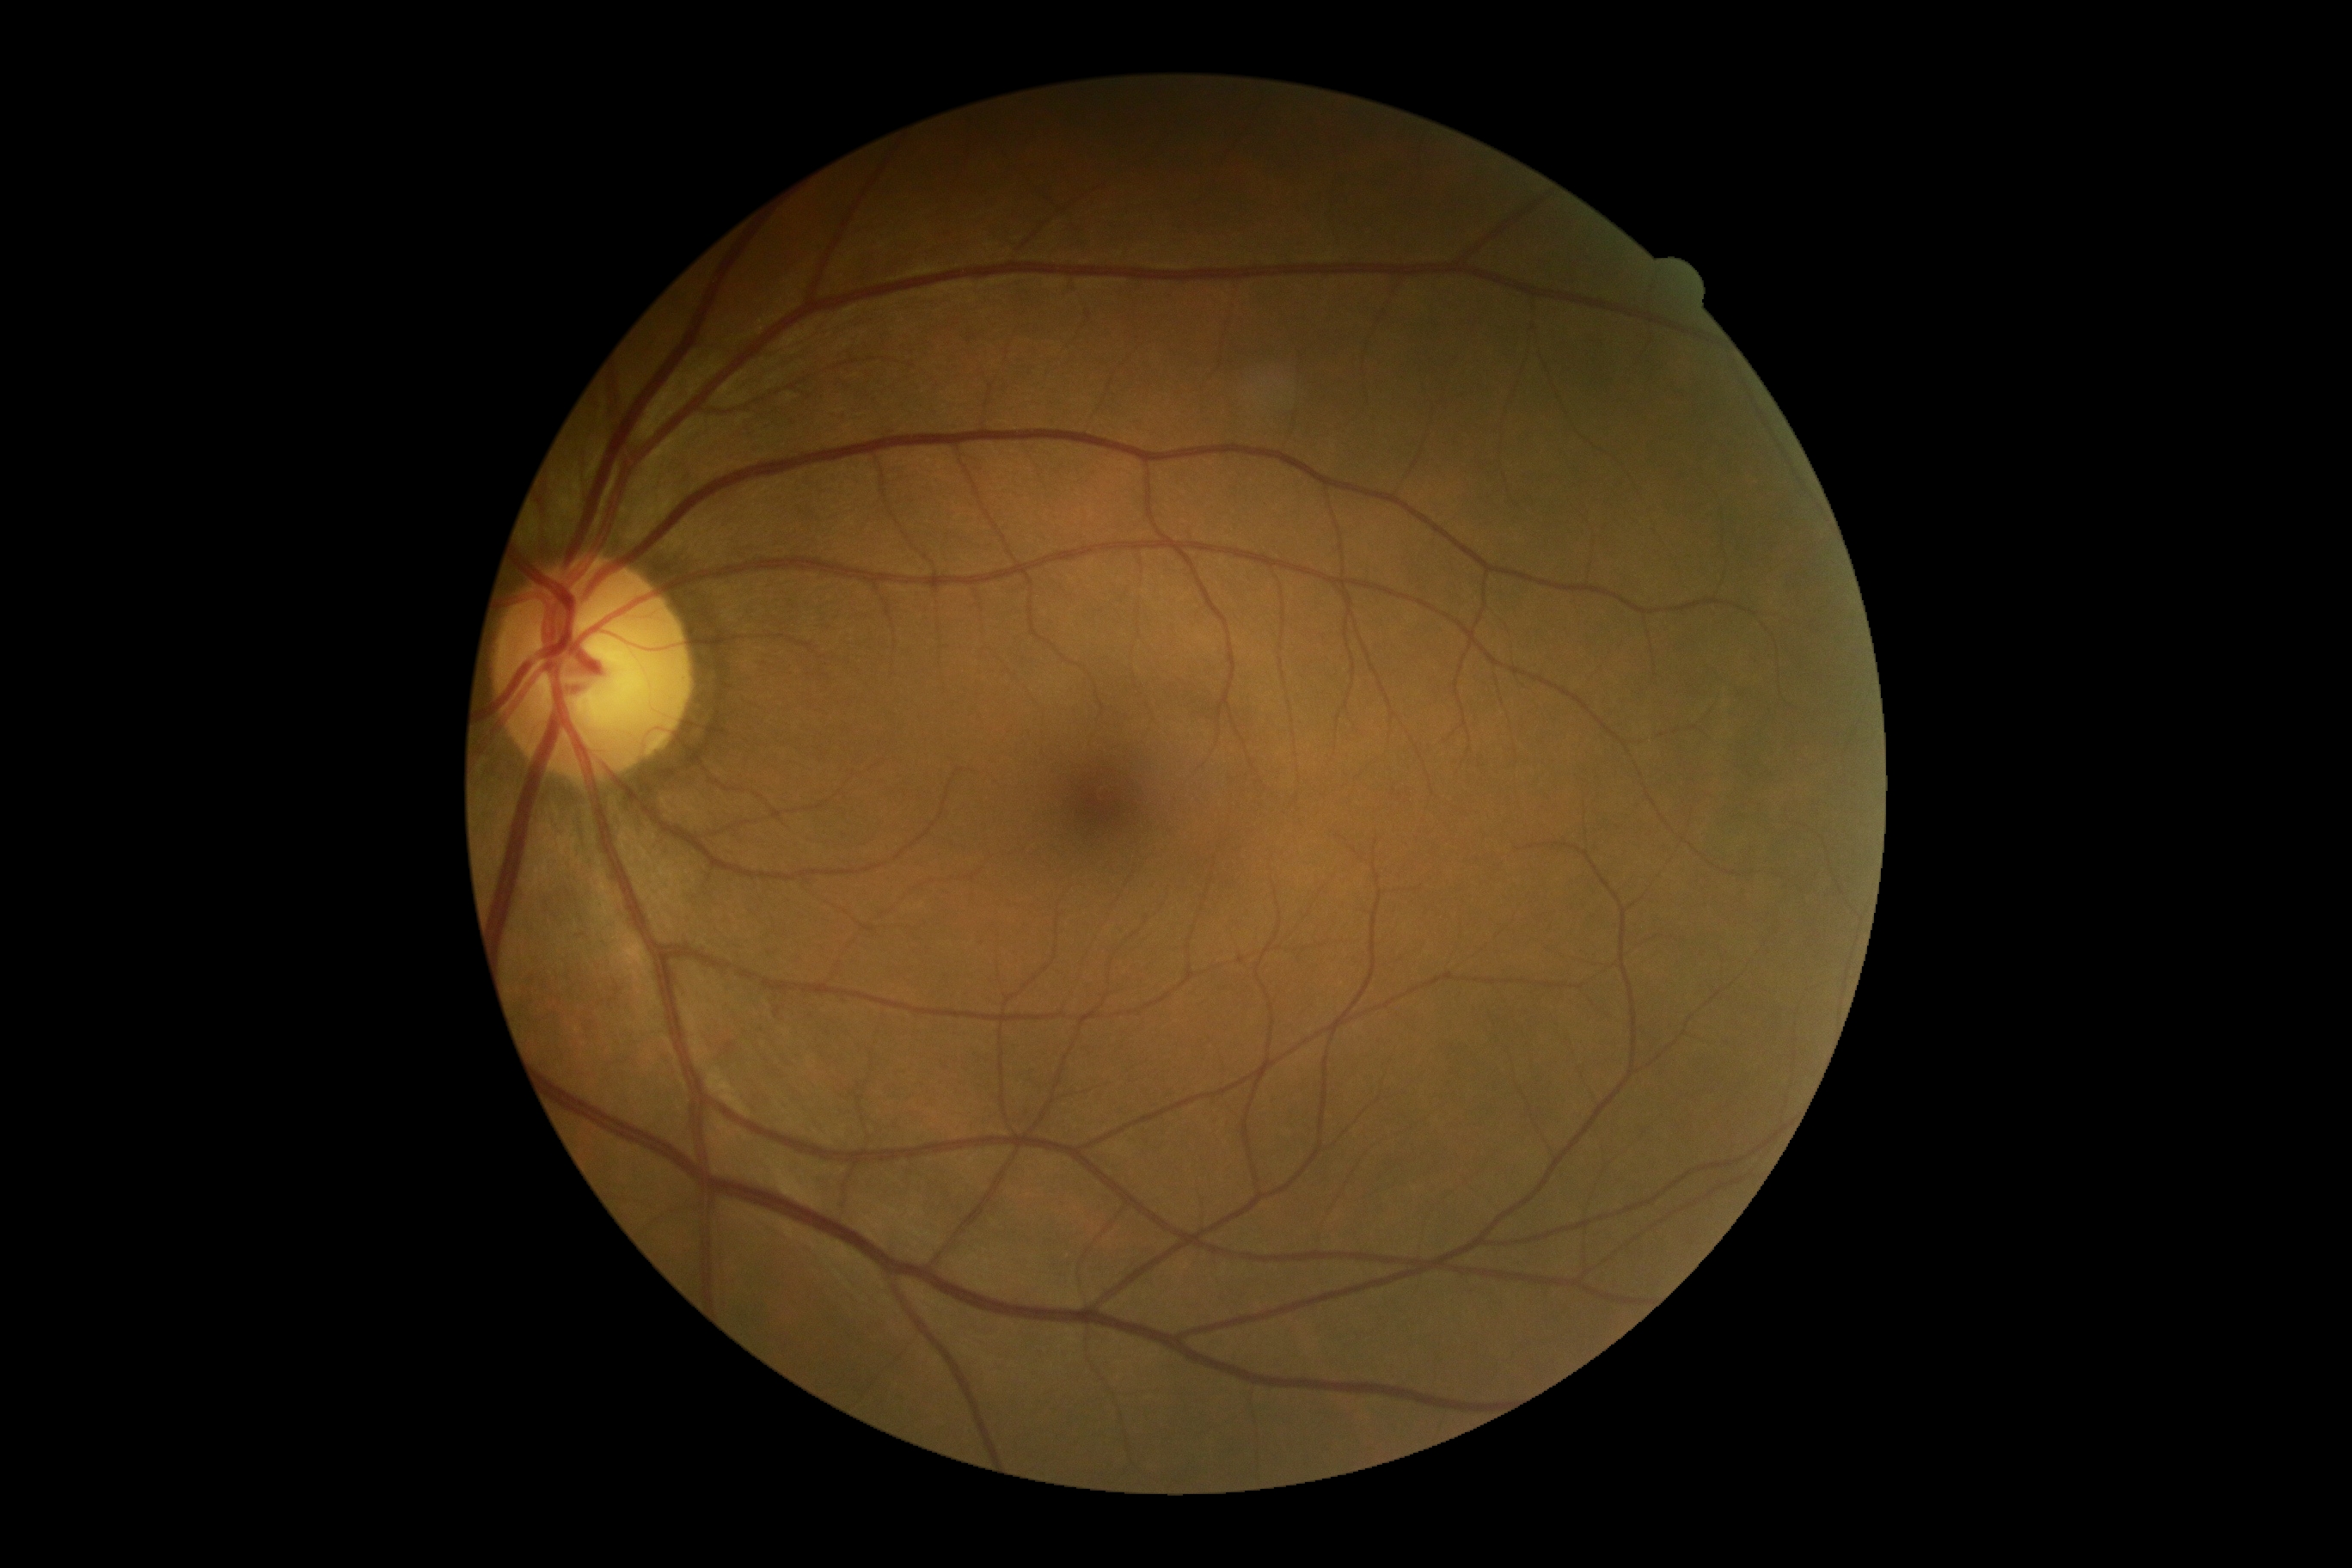
DR stage is grade 0.